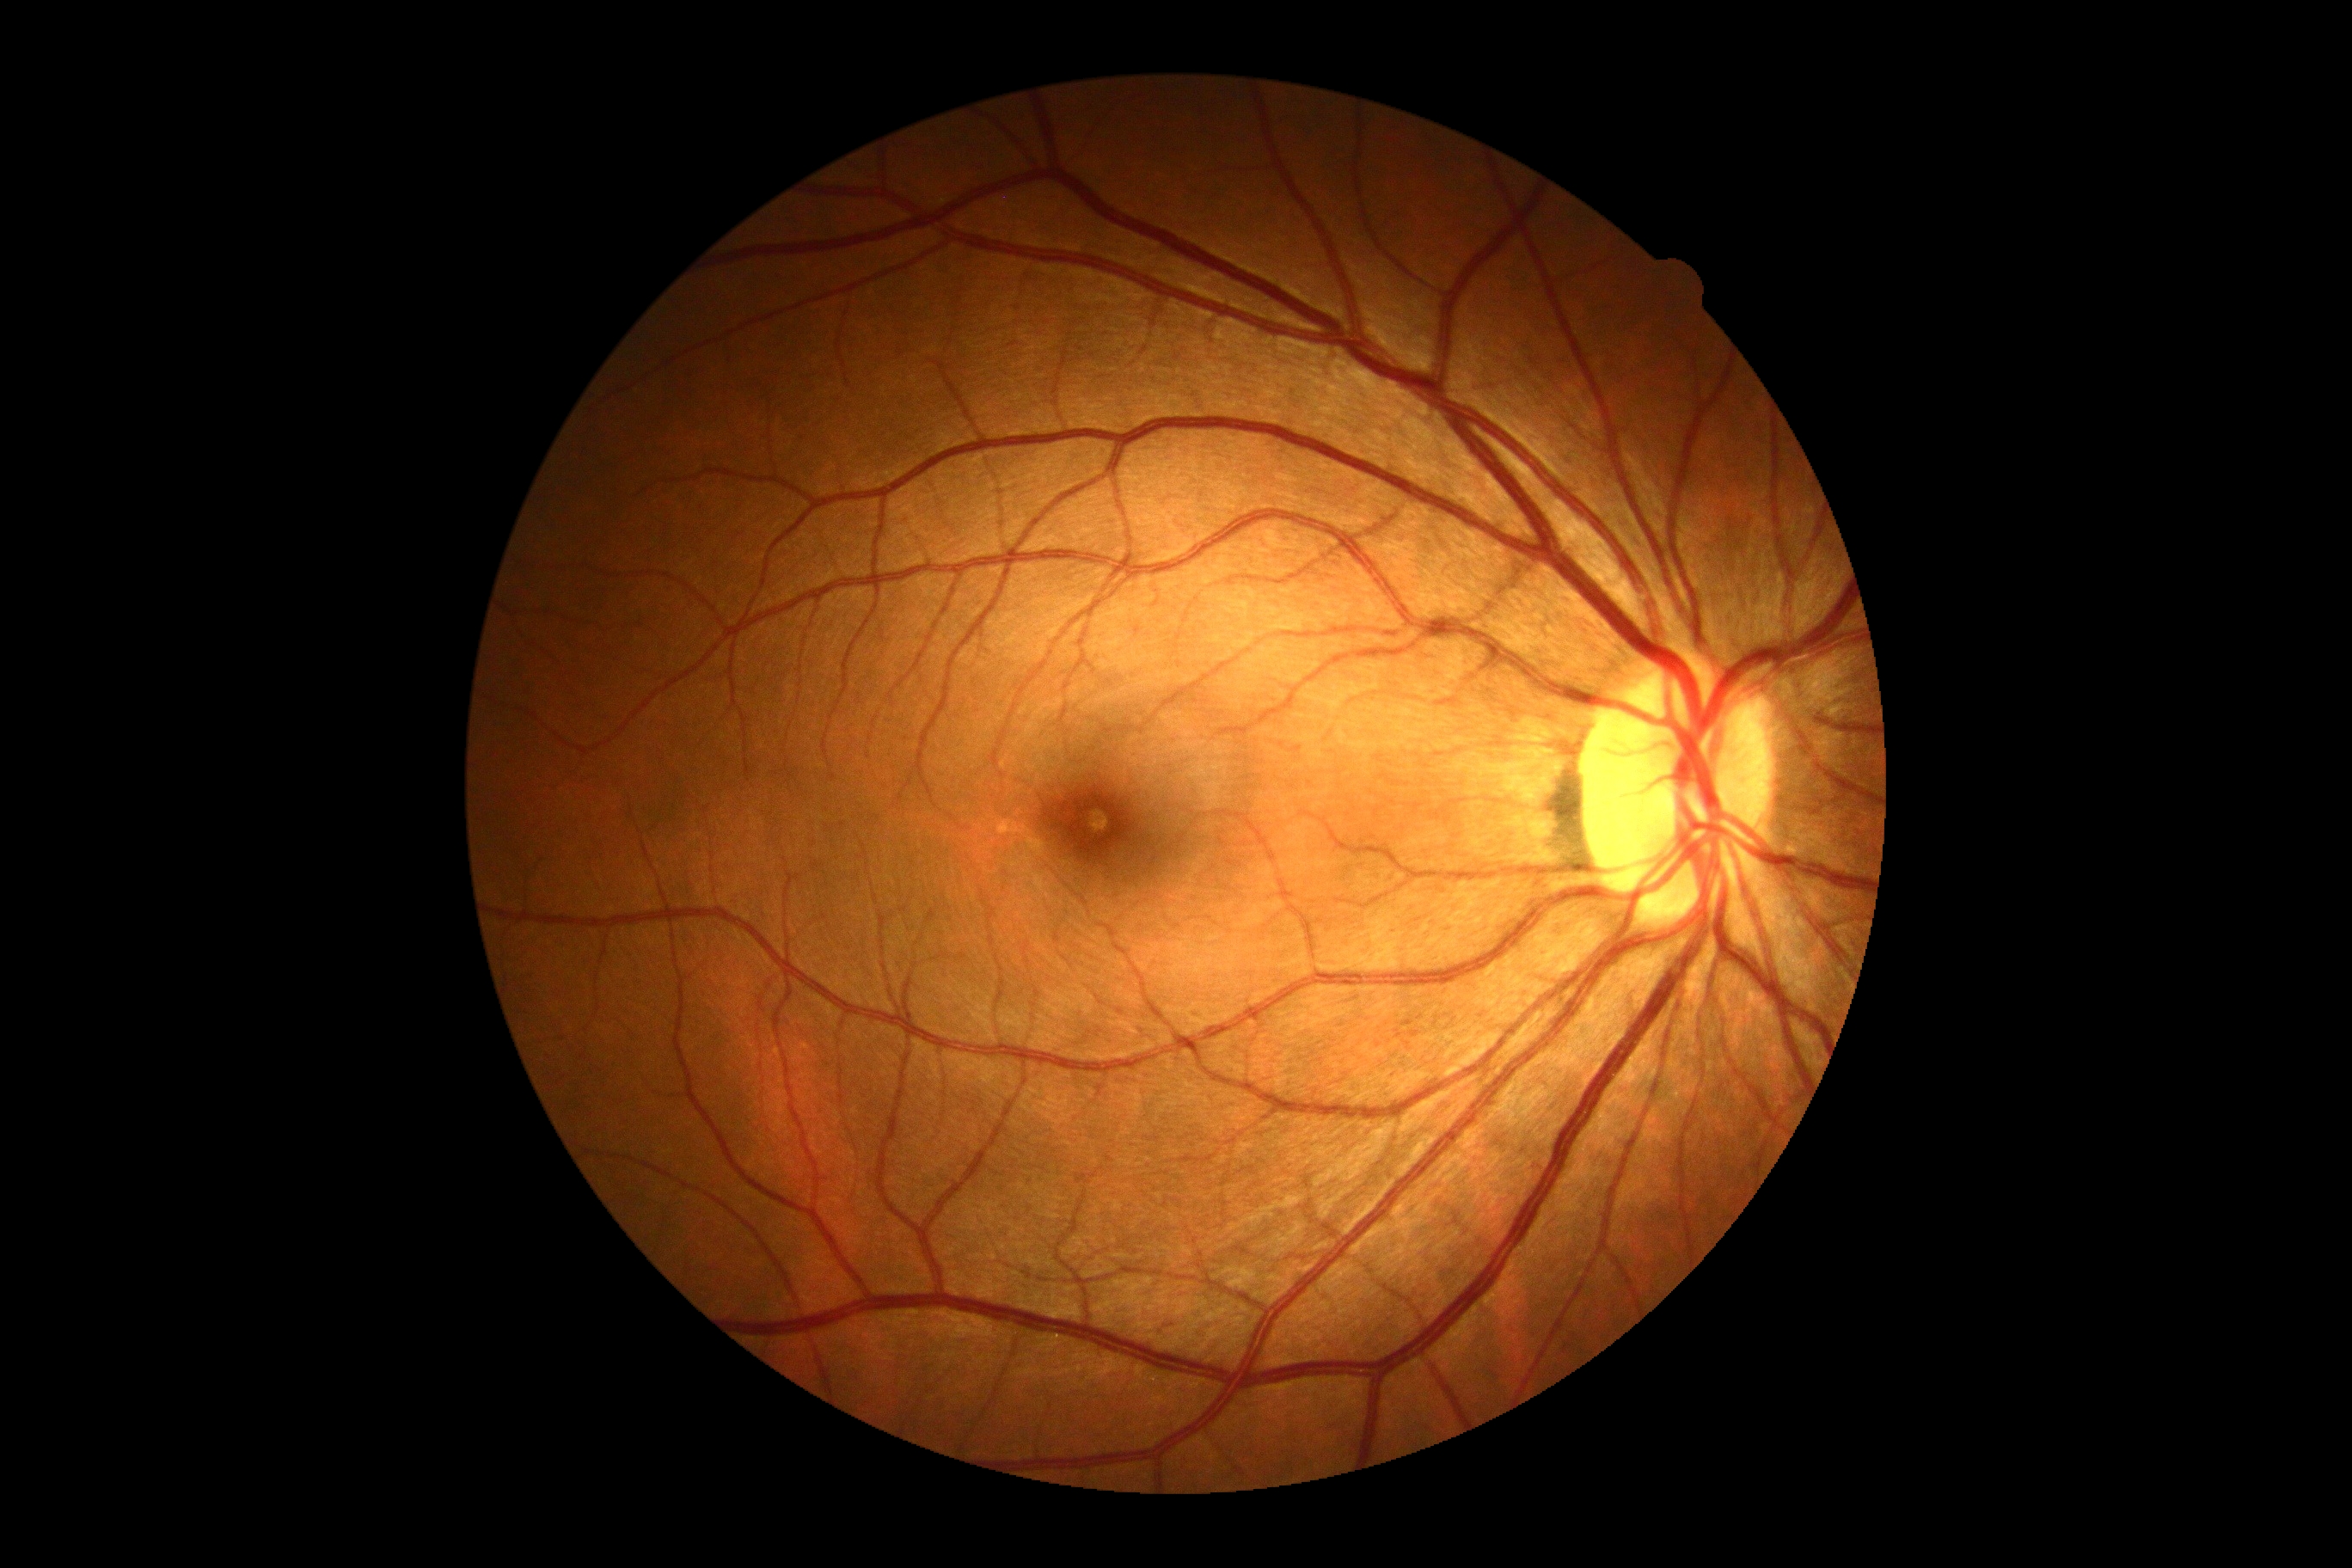 dr_impression: negative for DR
dr_grade: grade 0